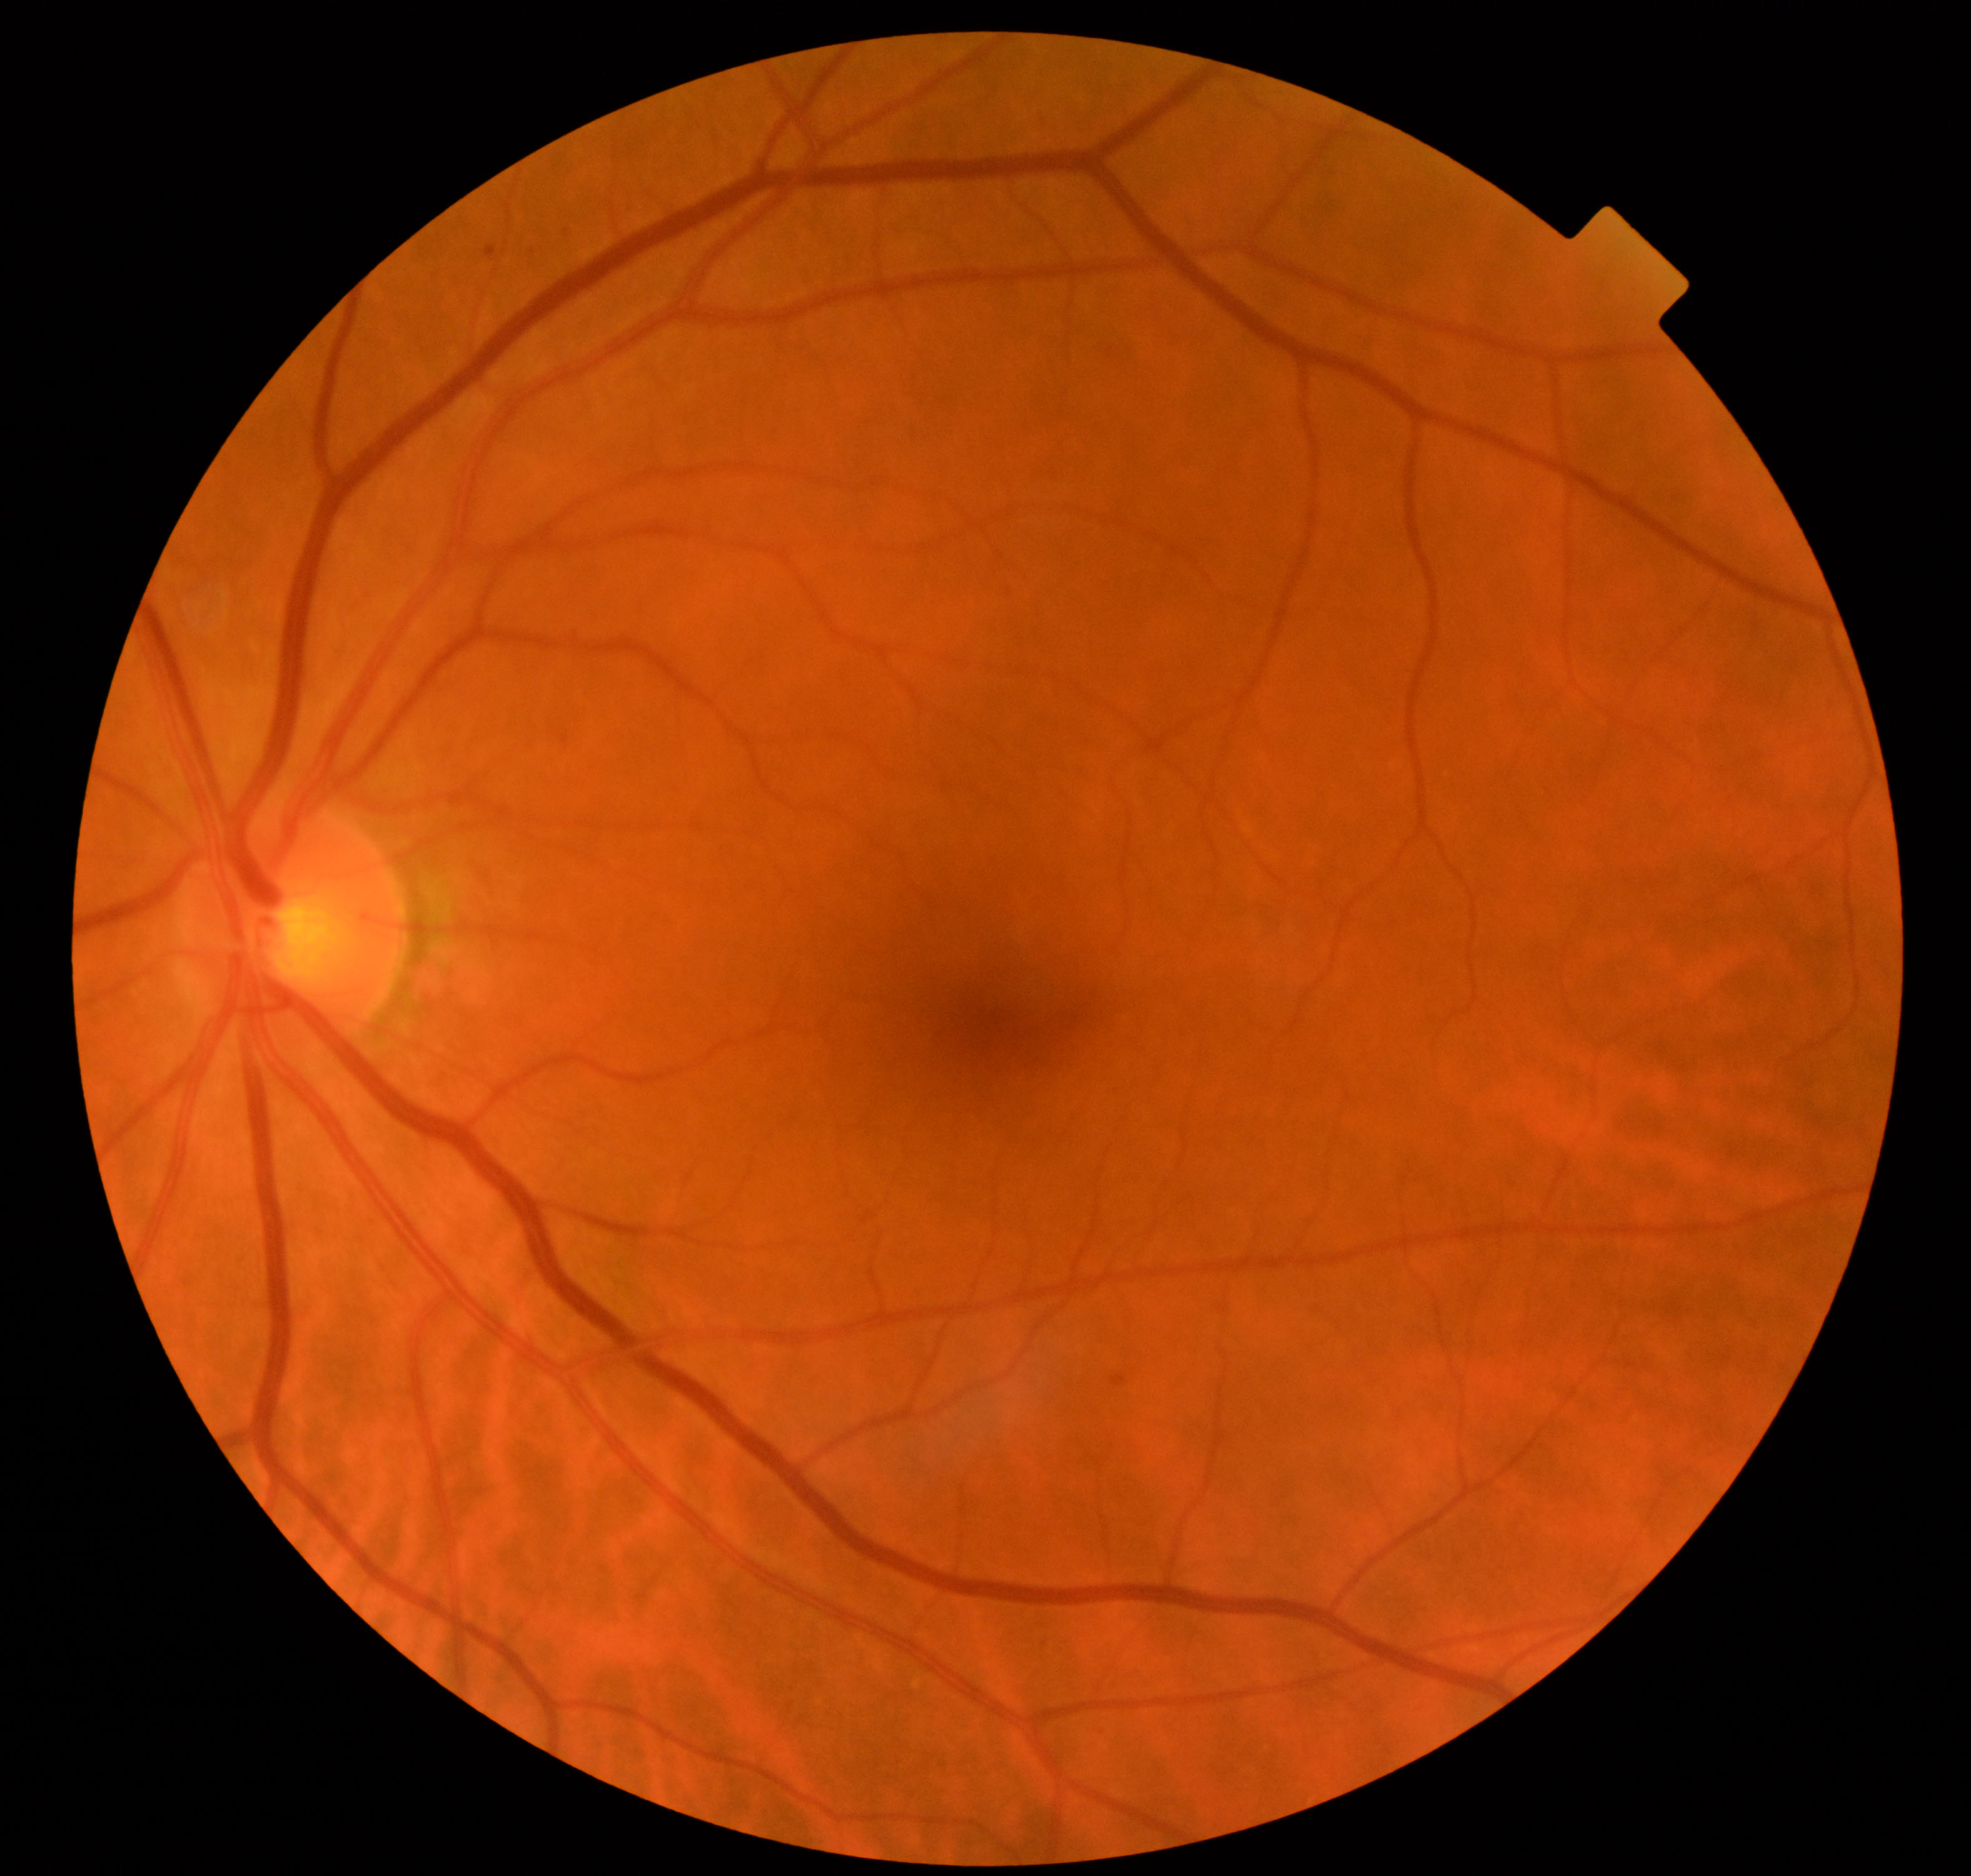
Retinal fundus photograph demonstrating mild non-proliferative diabetic retinopathy.